Nonmydriatic fundus photograph, fundus photo, Davis DR grading, 45° FOV:
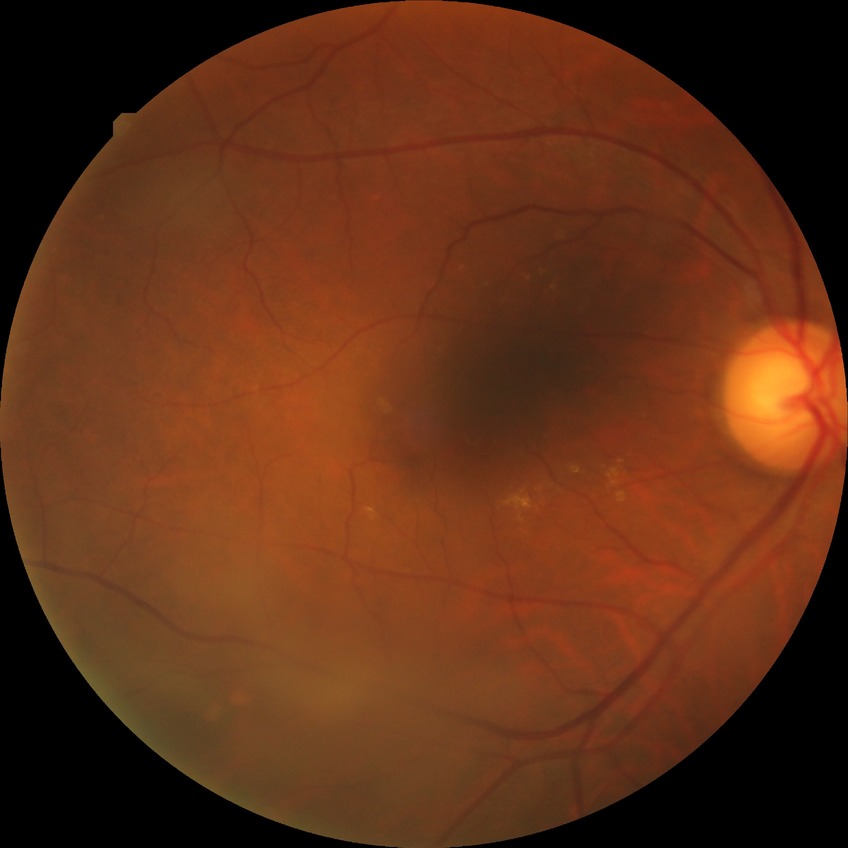
diabetic retinopathy (DR): NDR (no diabetic retinopathy).